Diabetic retinopathy graded by the modified Davis classification — 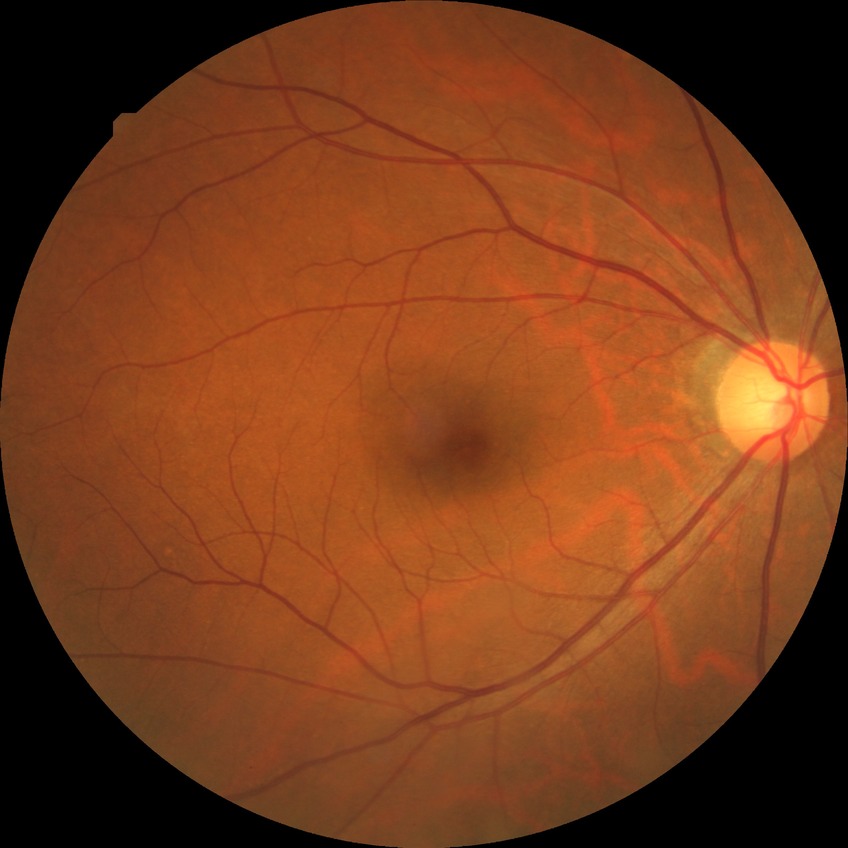

No diabetic retinal disease findings.
DR stage is NDR.